Acquired with a NIDEK AFC-230. 45° field of view. Nonmydriatic. Modified Davis classification
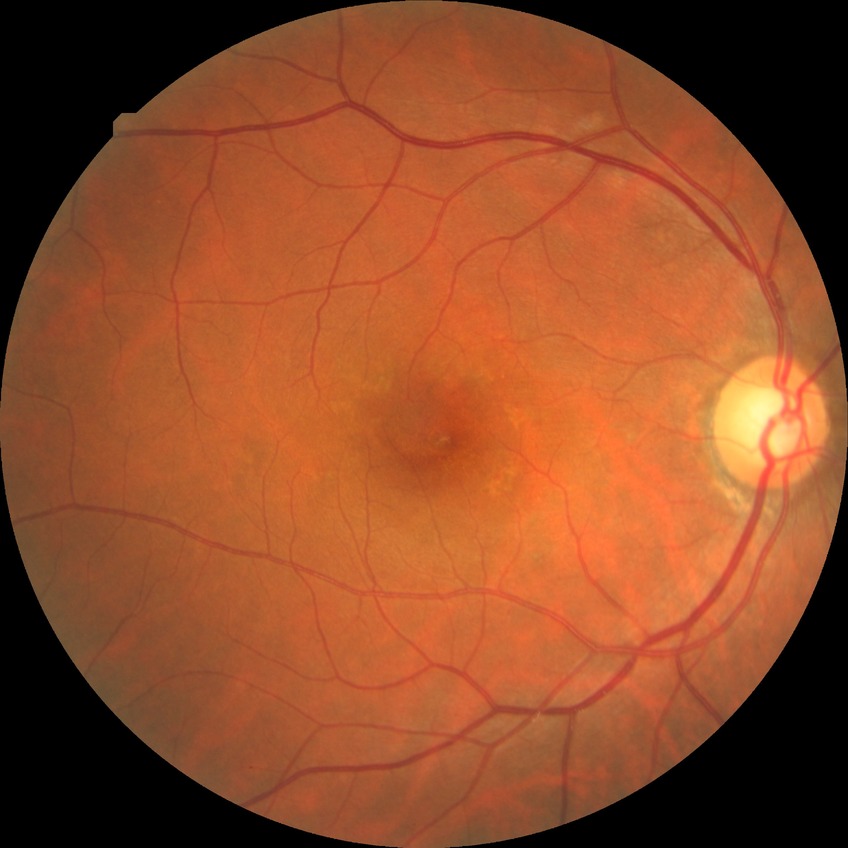

Retinopathy stage is simple diabetic retinopathy.